DR severity per modified Davis staging
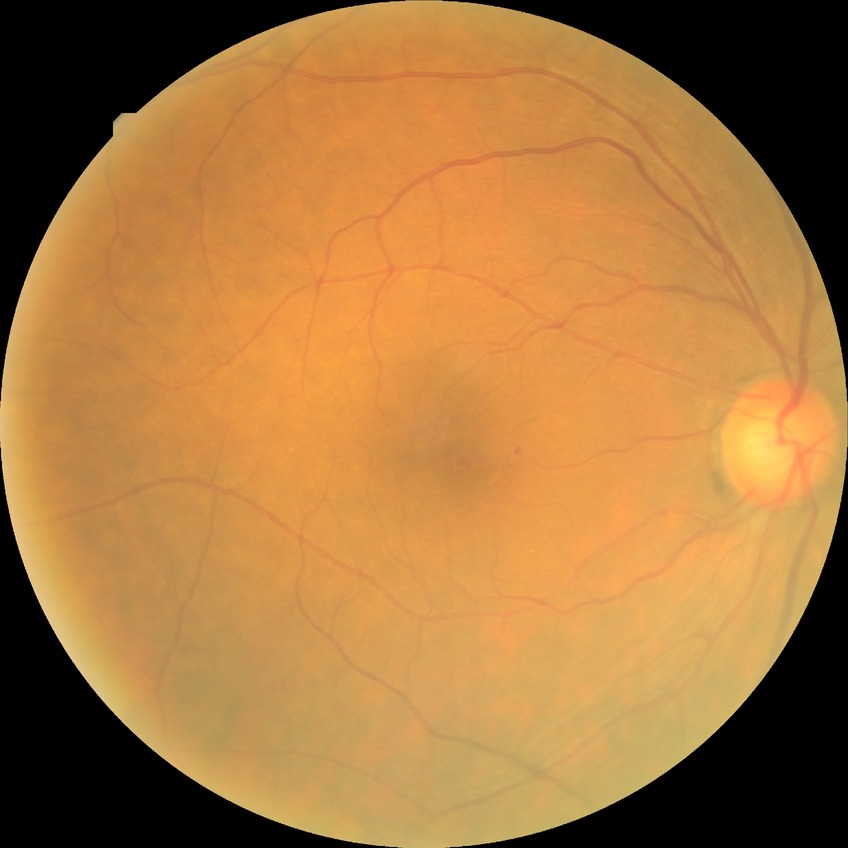
DR stage: NDR.
No apparent diabetic retinopathy.